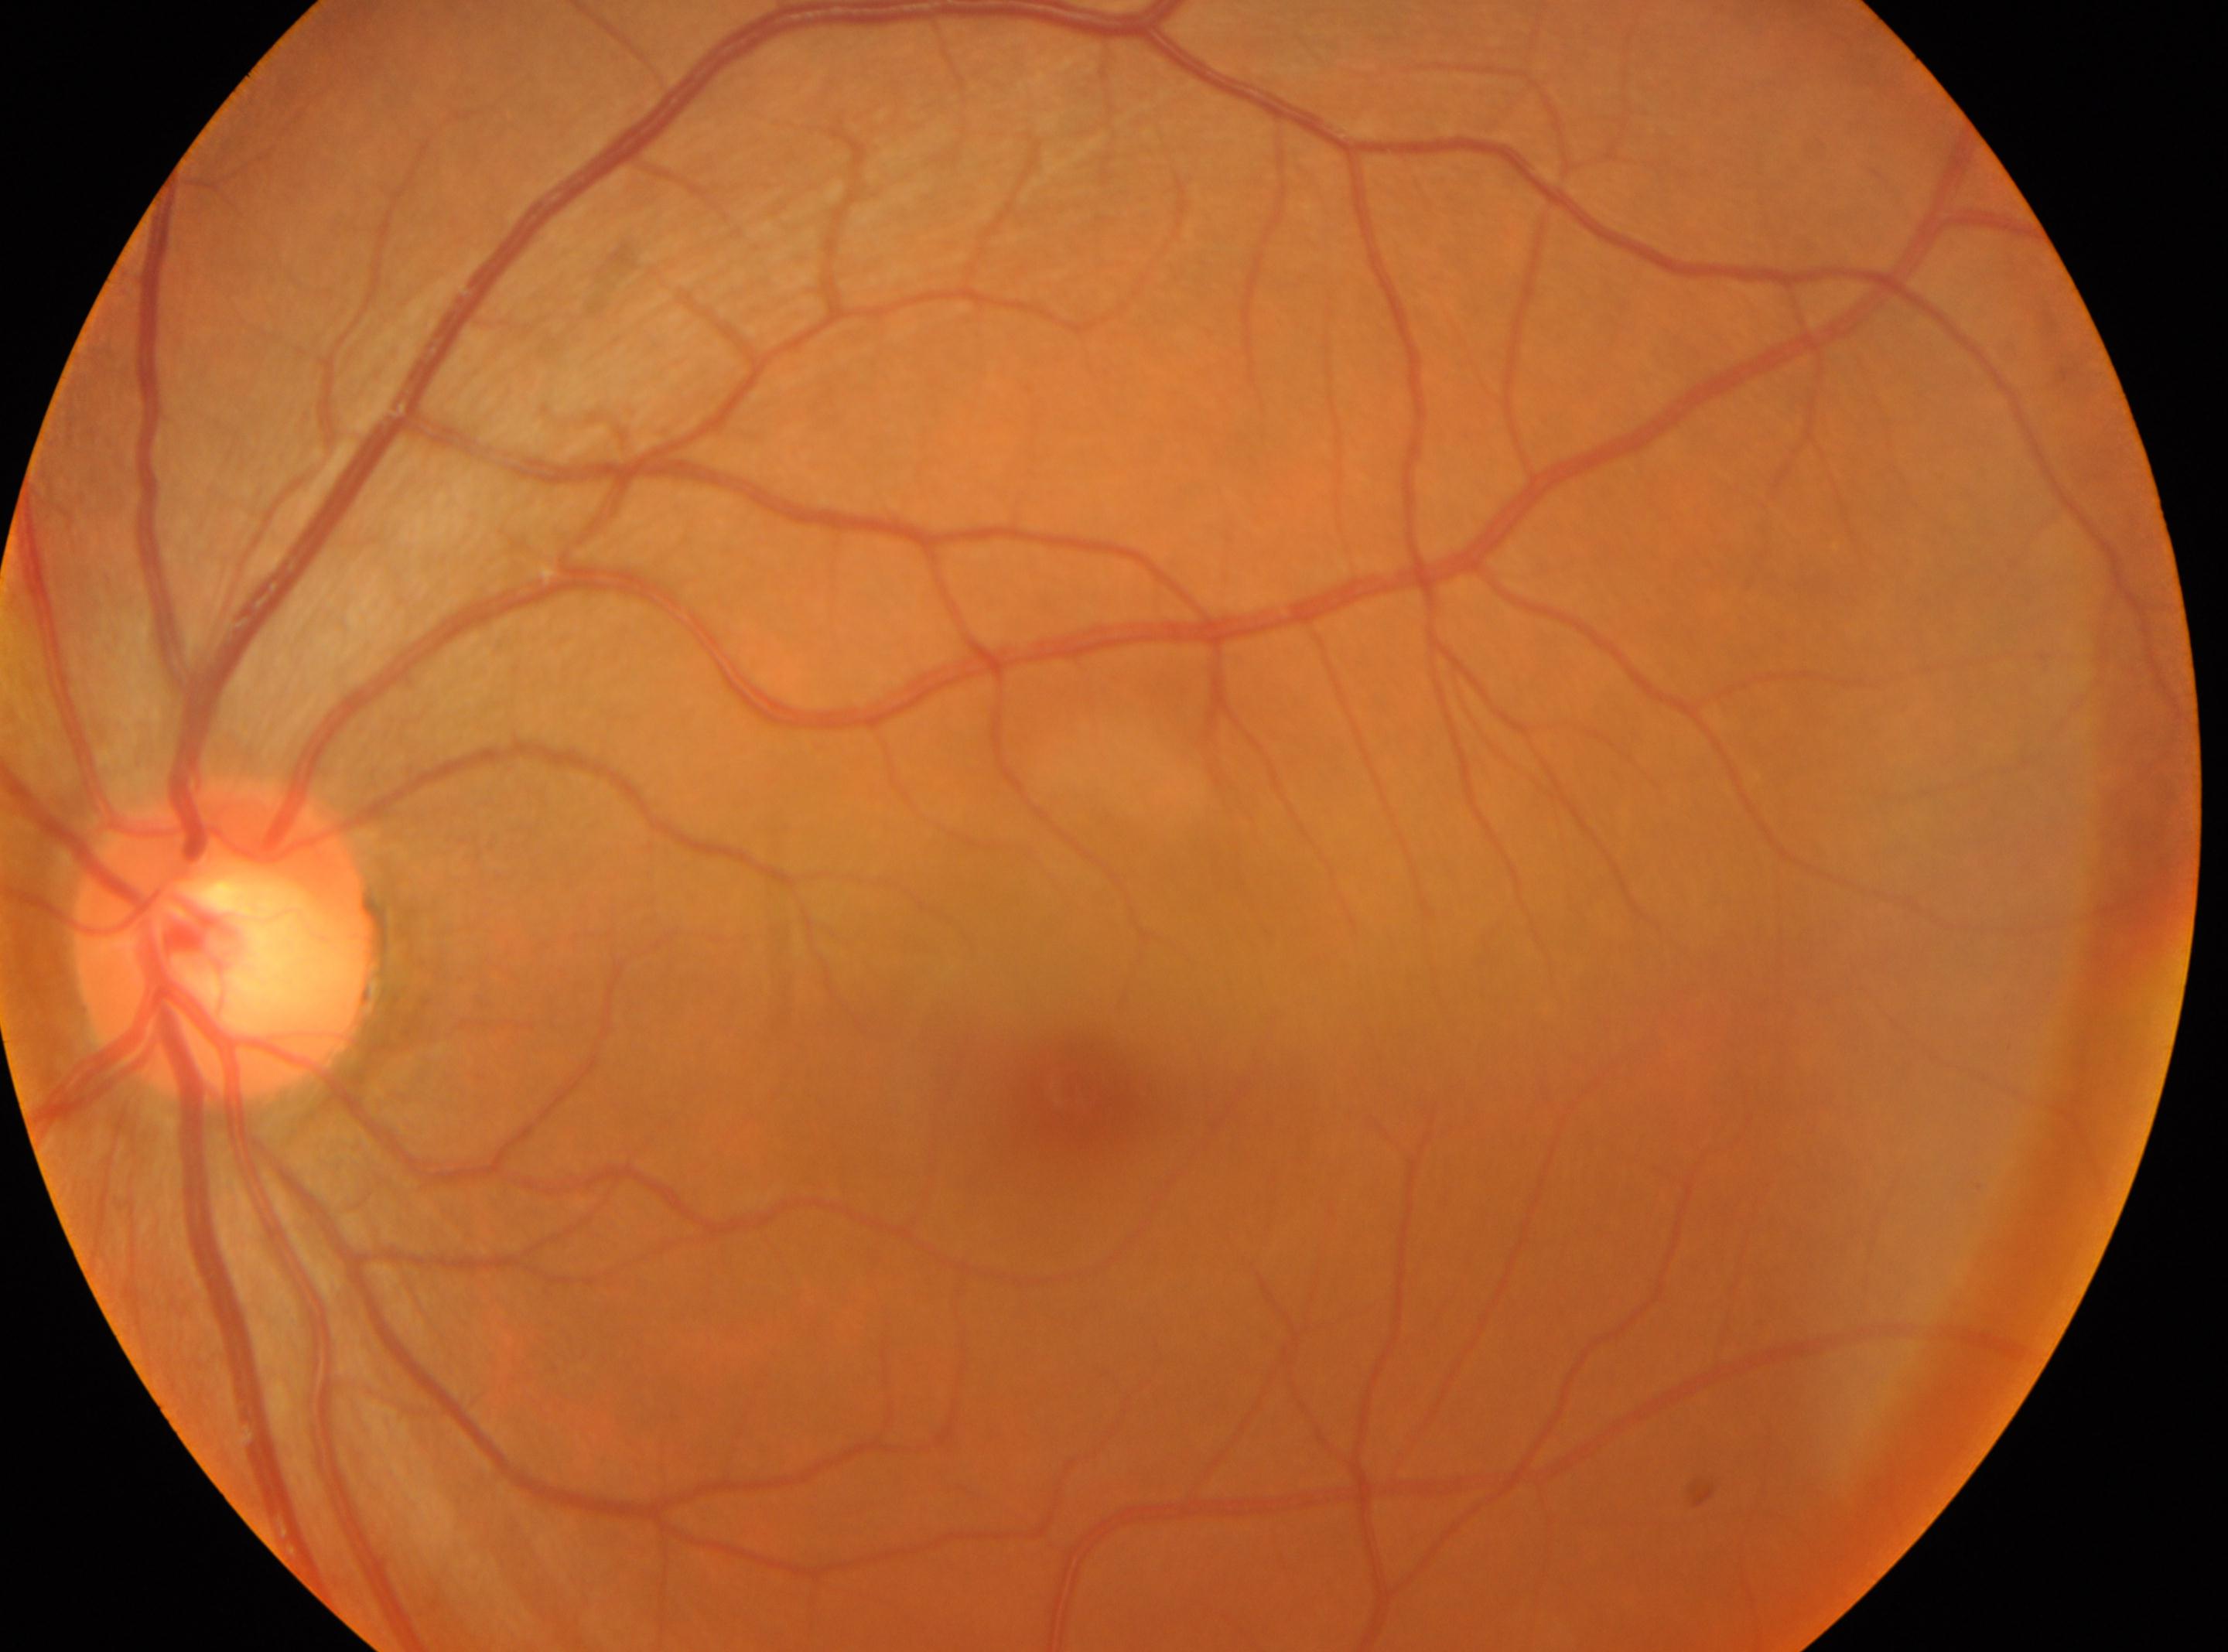

The image shows the OS. Macula center: (1072,1084). No diabetic retinopathy identified. Diabetic retinopathy (DR): 0. The disc center is at (225,940).